45-degree field of view, camera: NIDEK AFC-230.
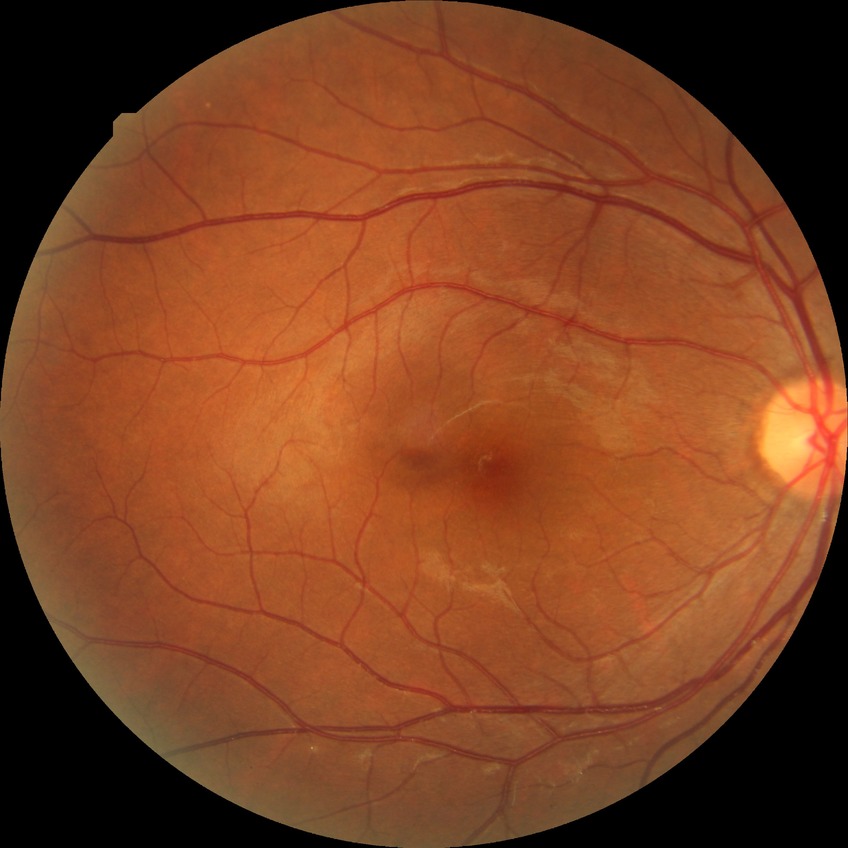

Retinopathy stage is no diabetic retinopathy.